Color fundus photograph. 2212x1659px.
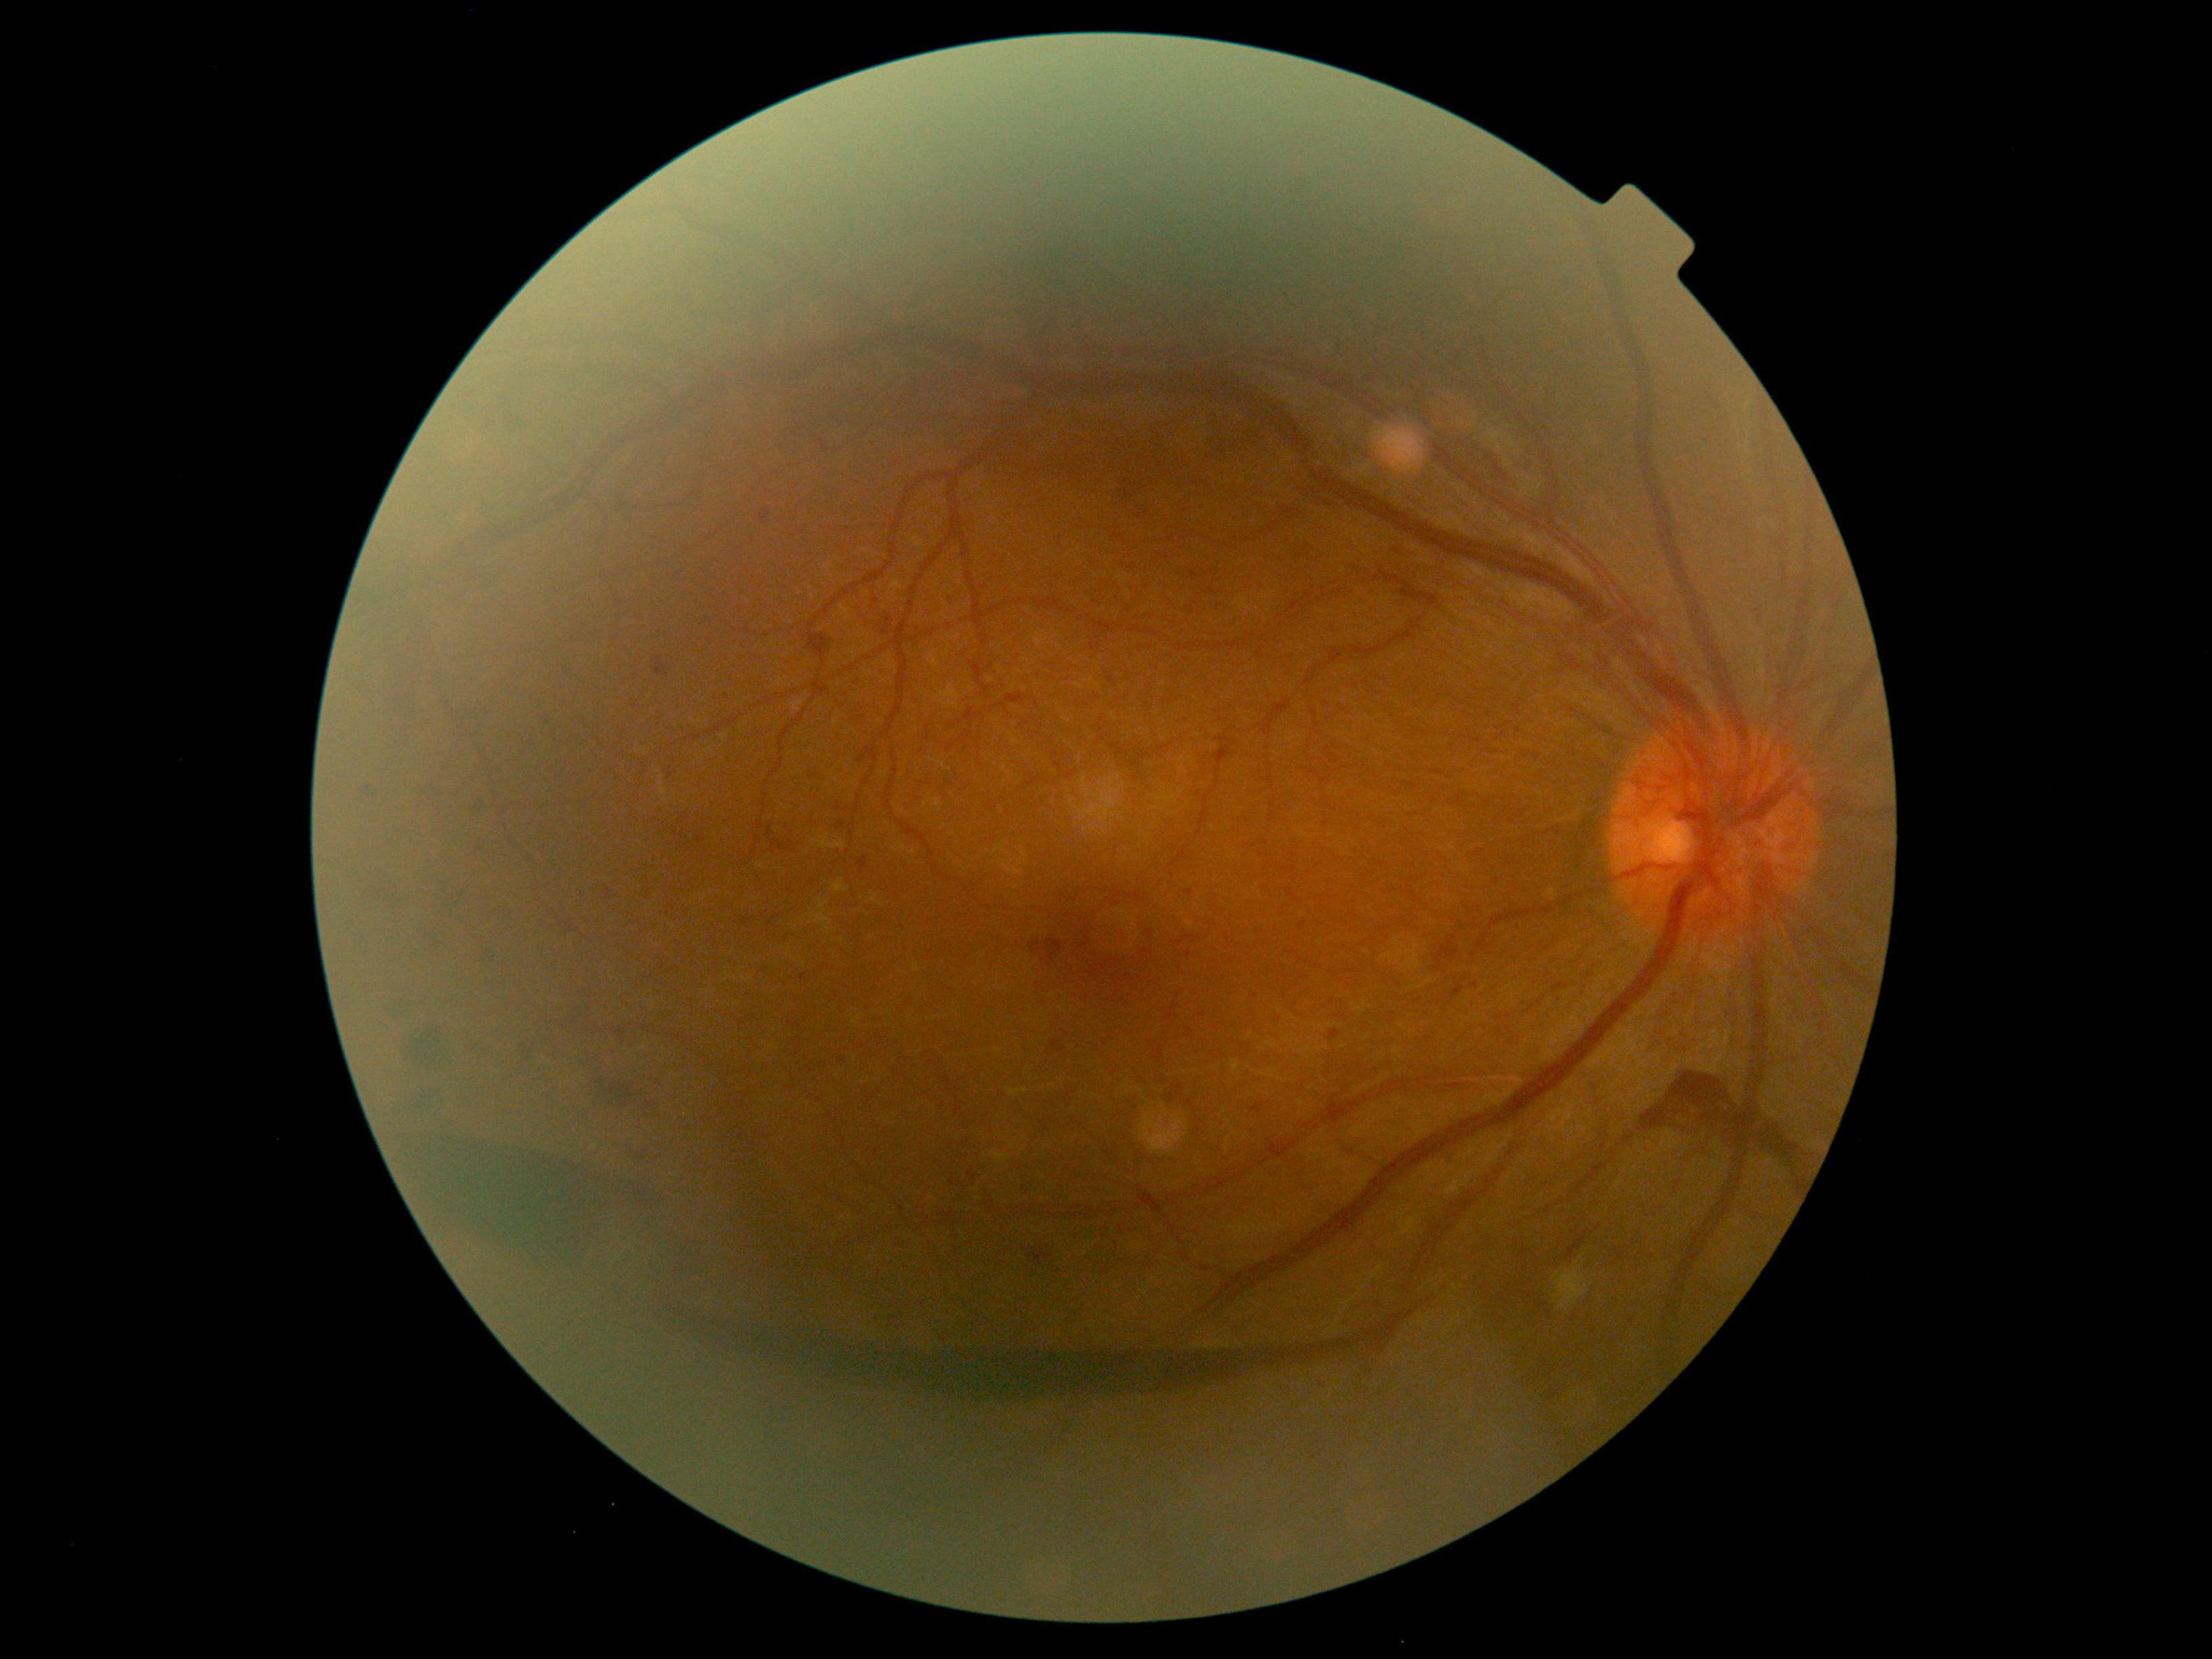

DR: 4/4 — neovascularization and/or vitreous/pre-retinal hemorrhage.